Retinal fundus photograph. Image size 2102x1736
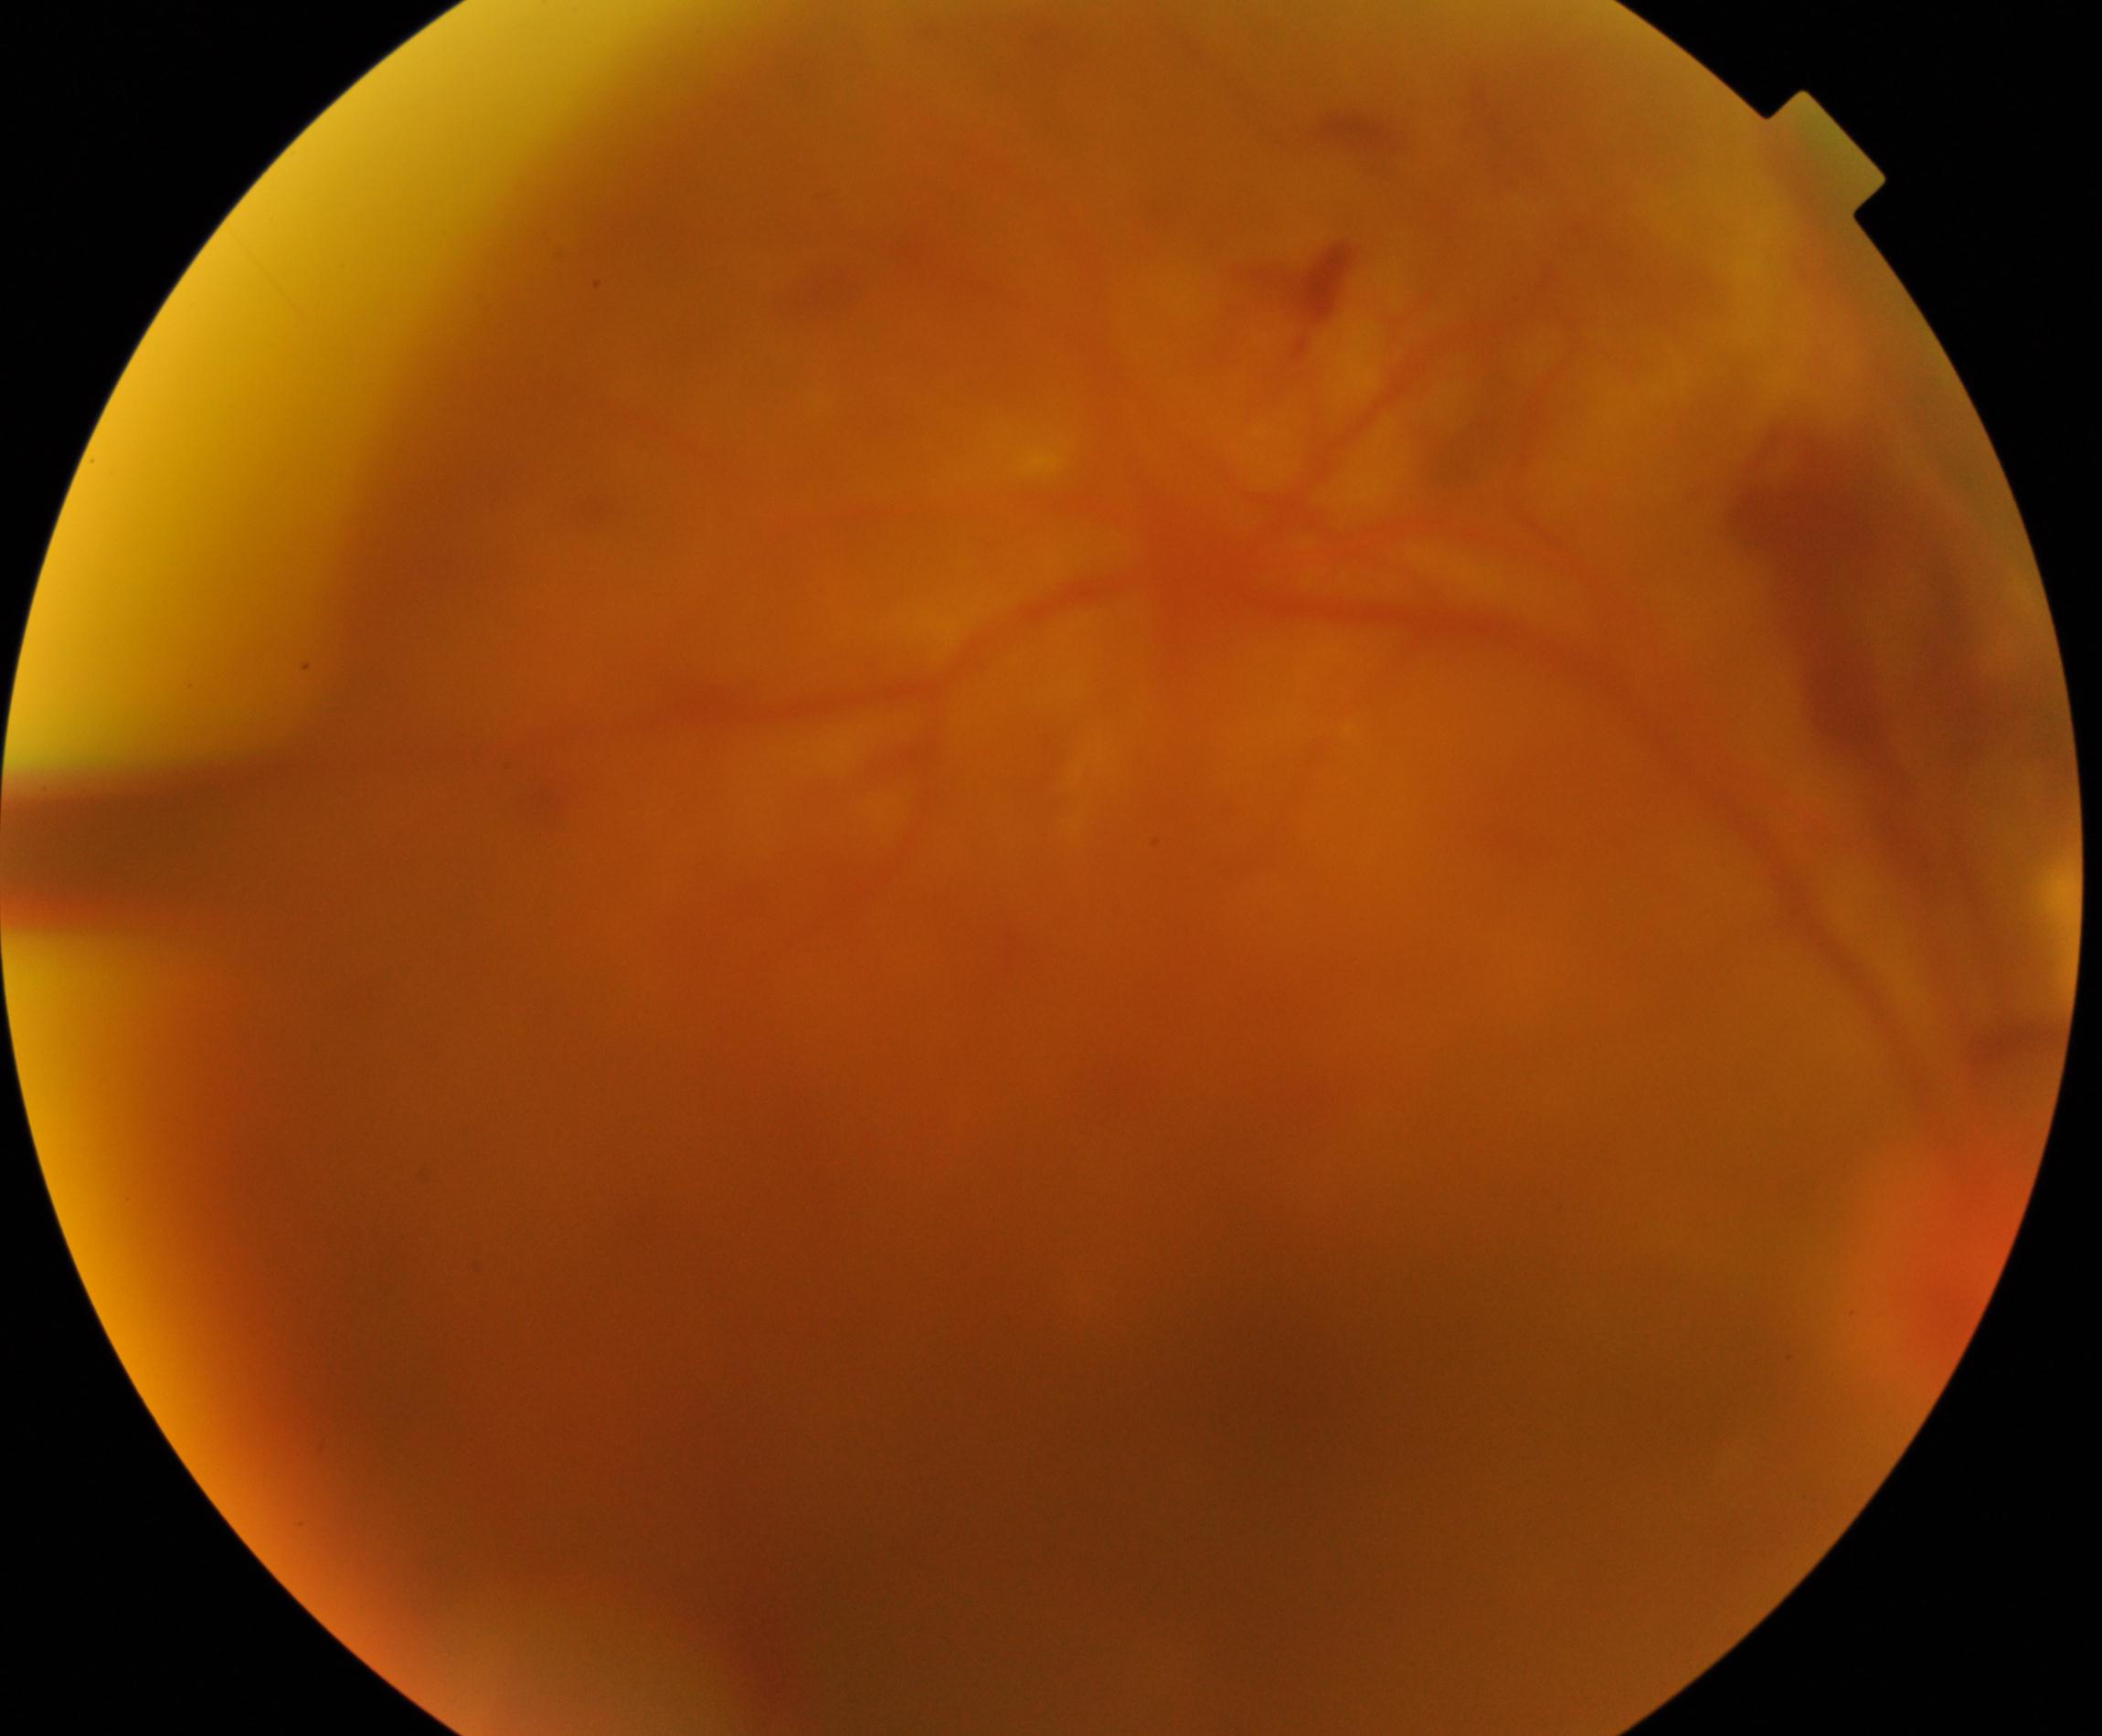

Significantly degraded image quality with obscured retinal detail. Features suspicious for proliferative diabetic retinopathy.